Fundus photo, 2048 x 1536 pixels — 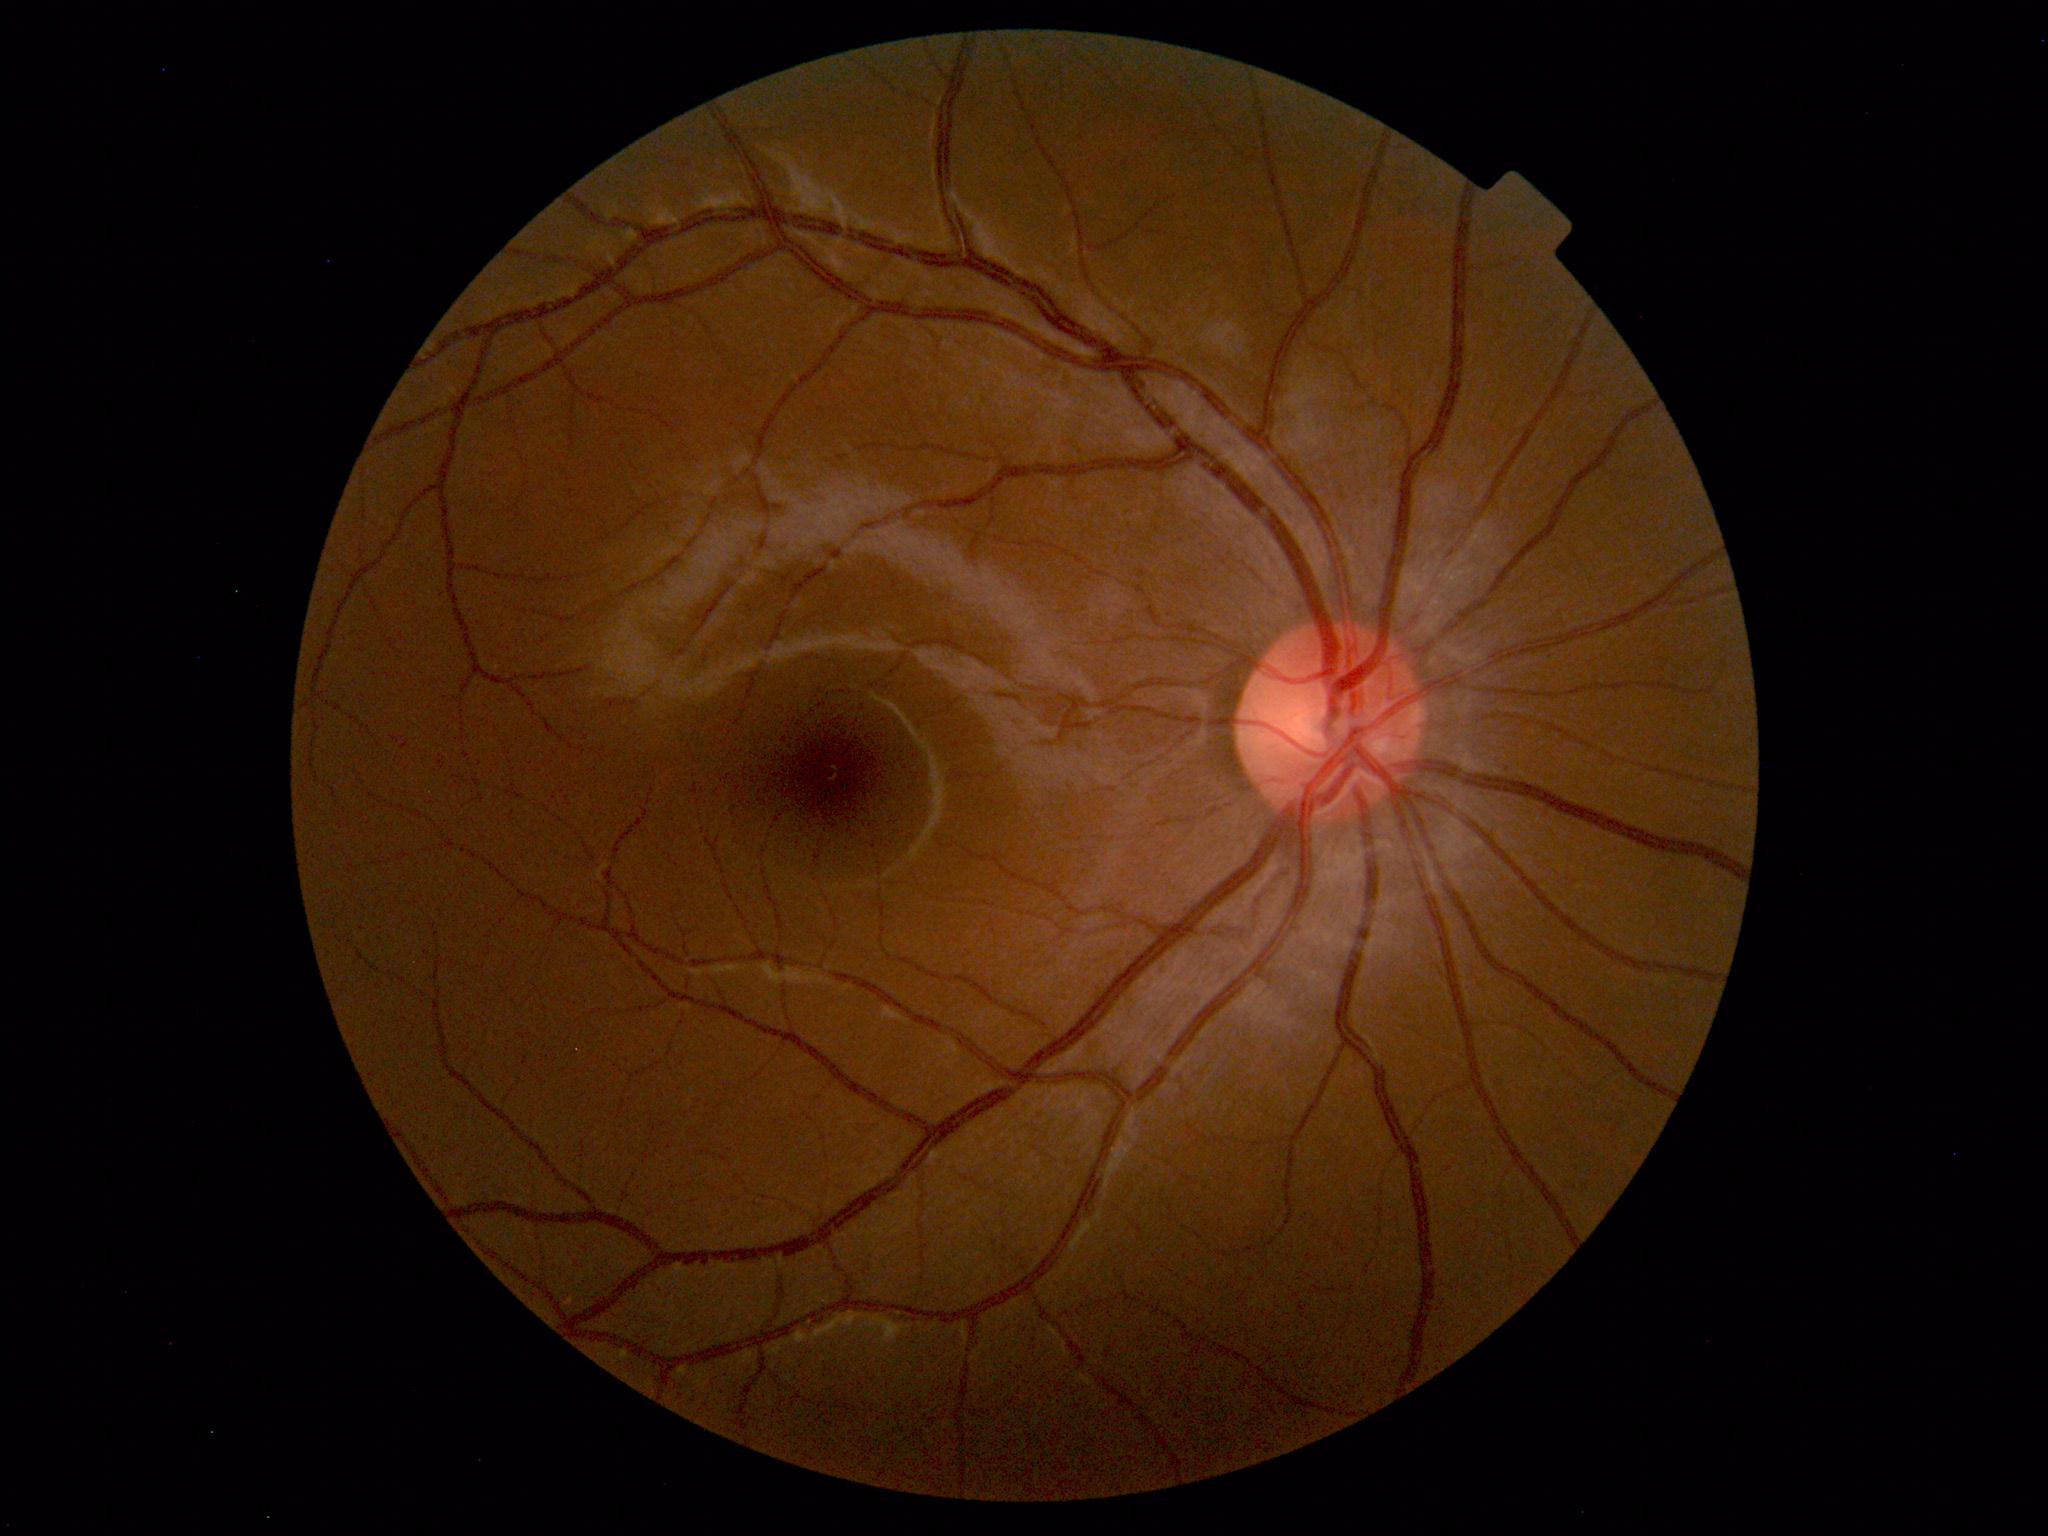
Normal fundus. No pathology identified.